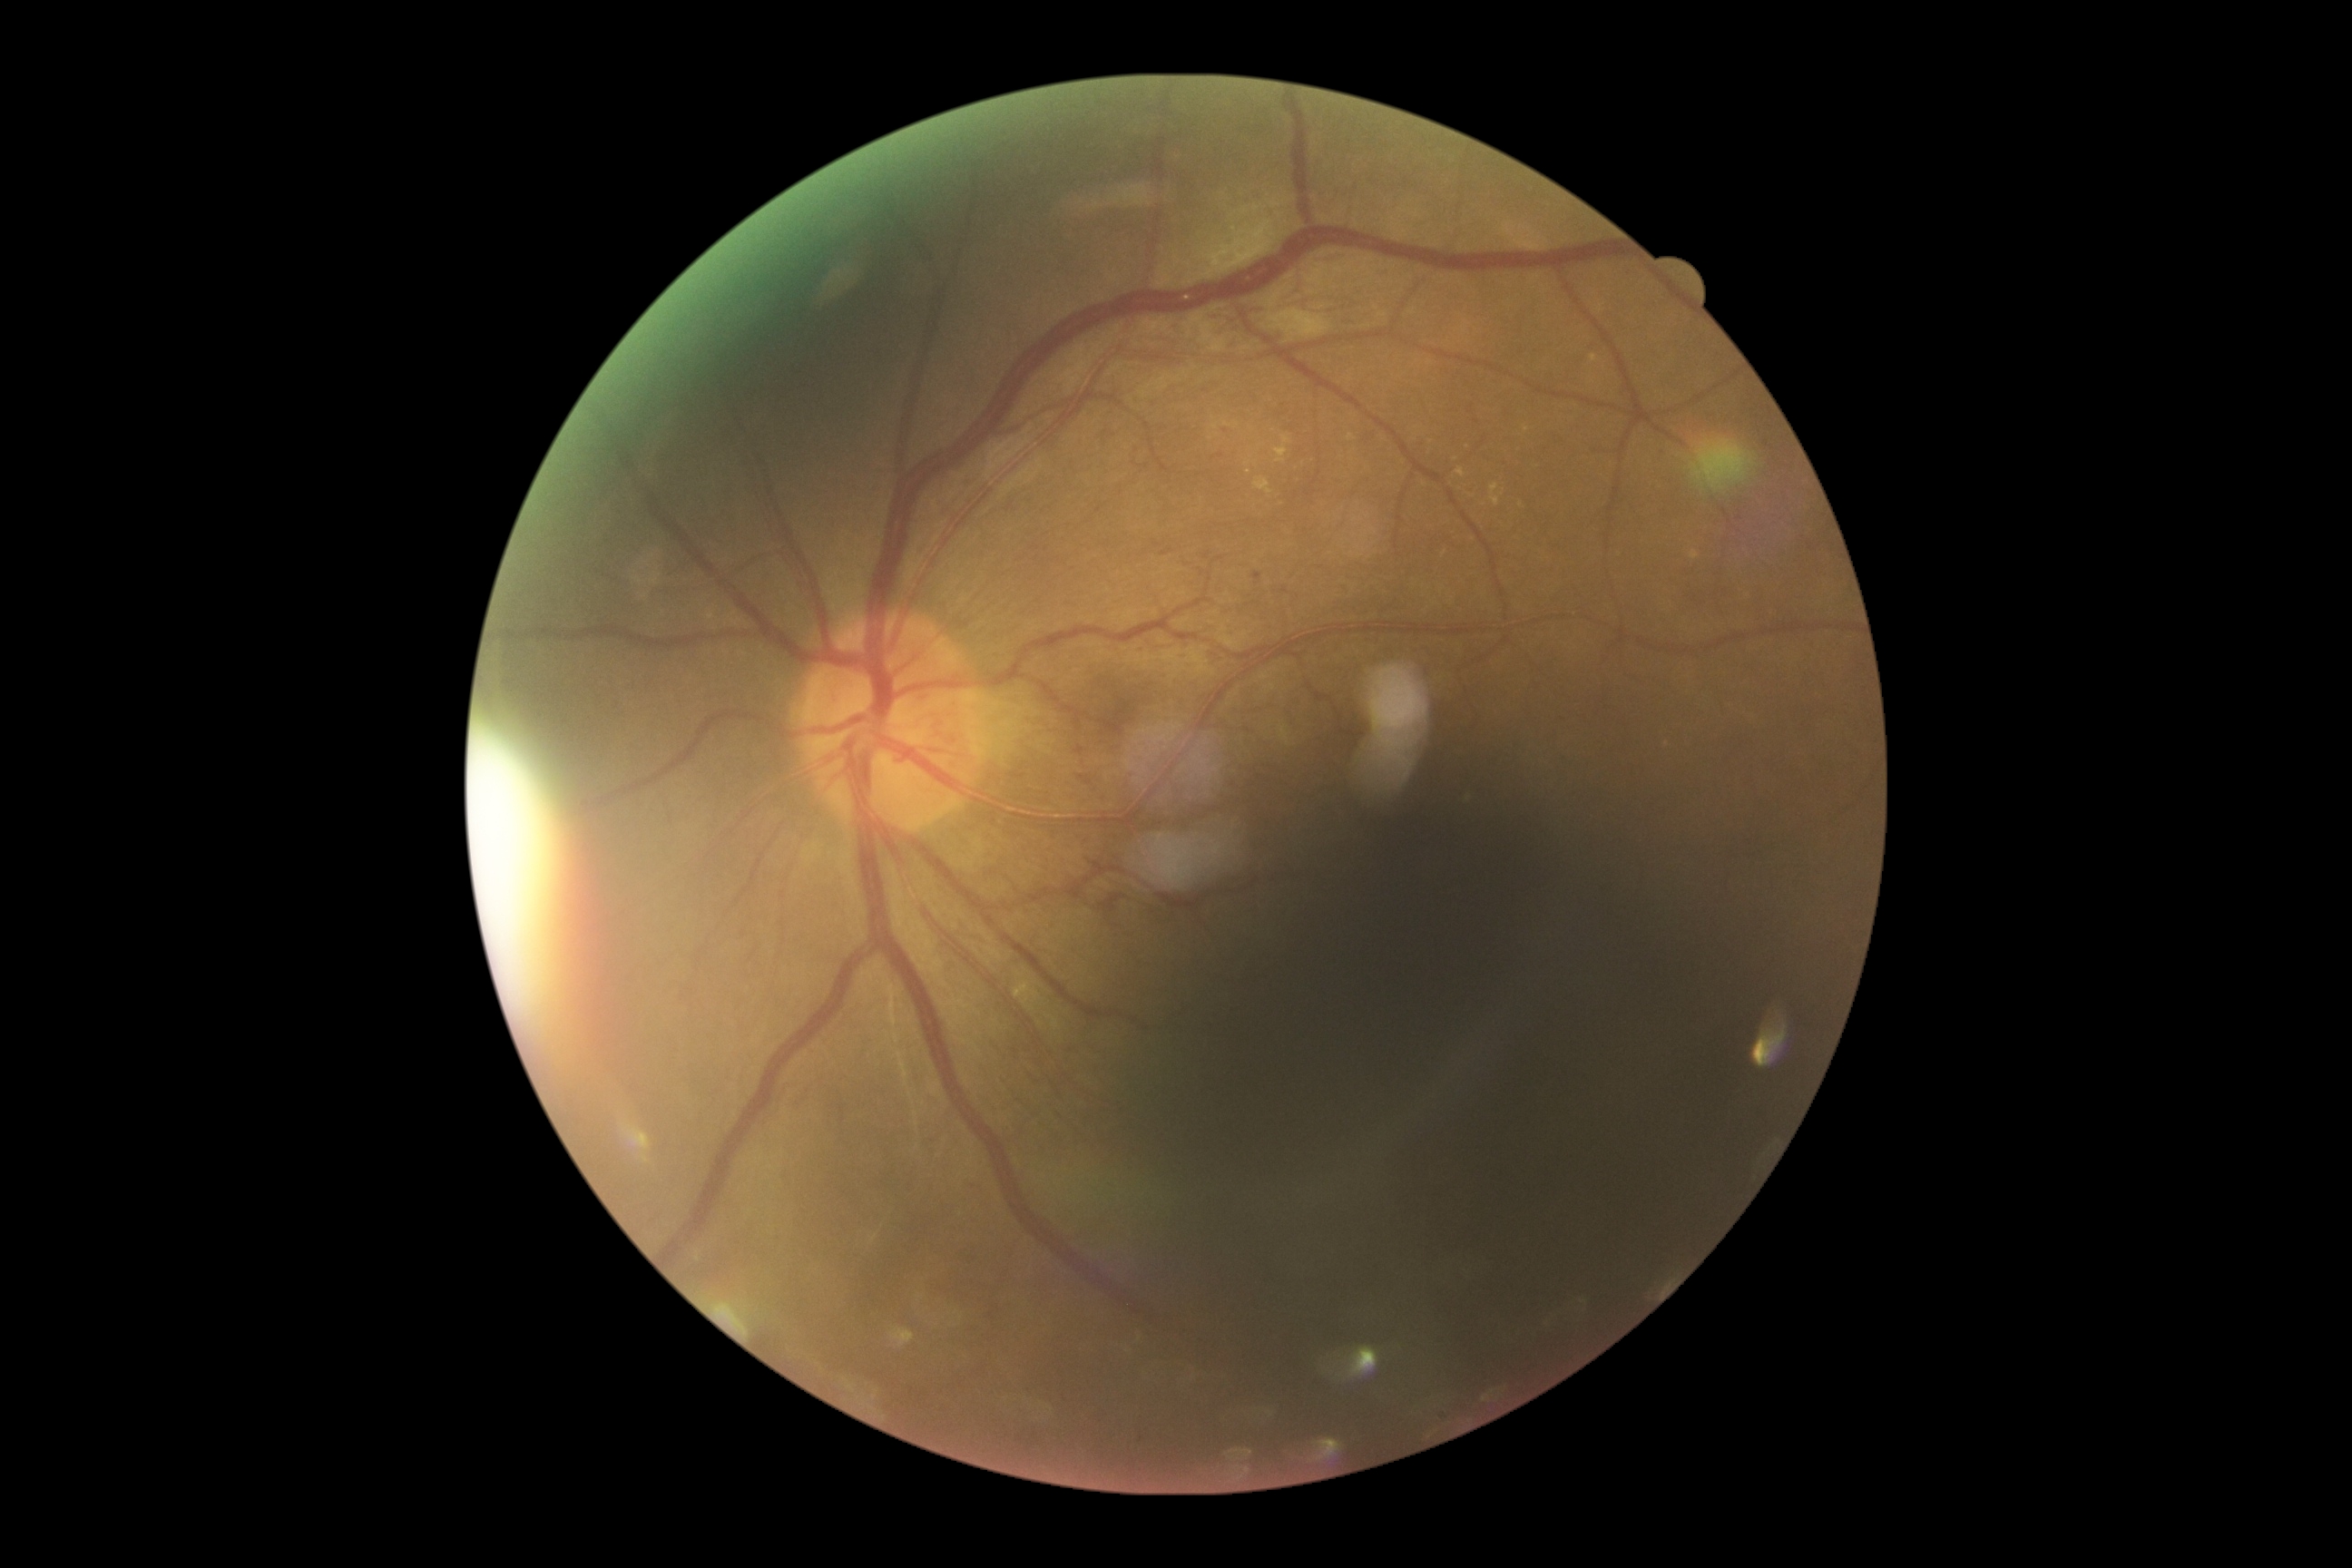
Diabetic retinopathy (DR) is grade 3.